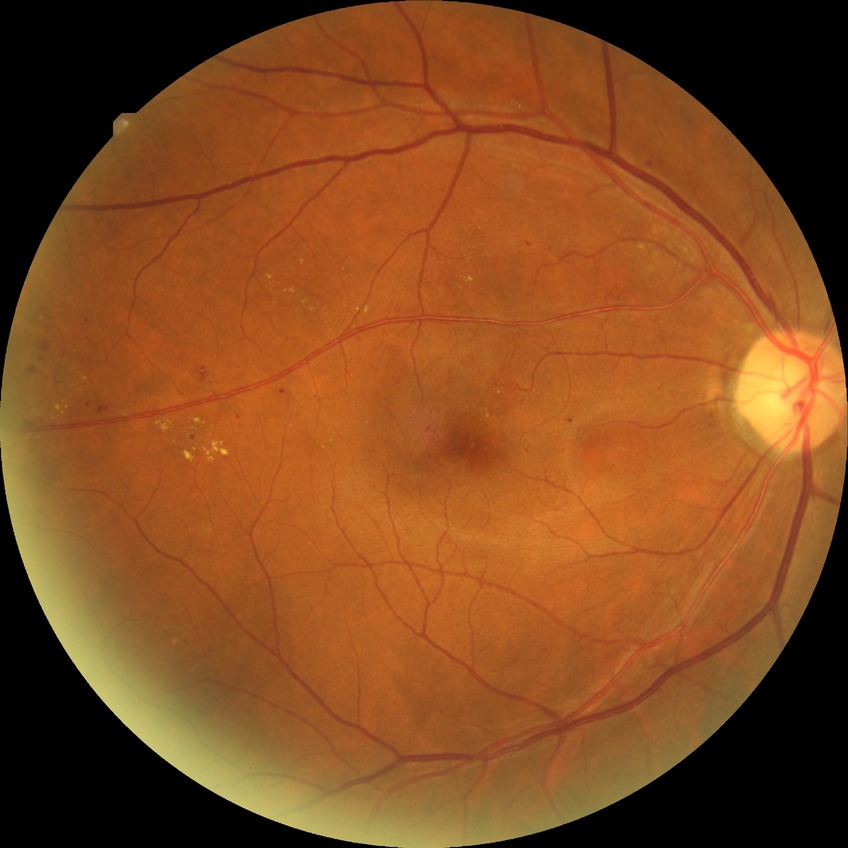
DR grade is PDR.